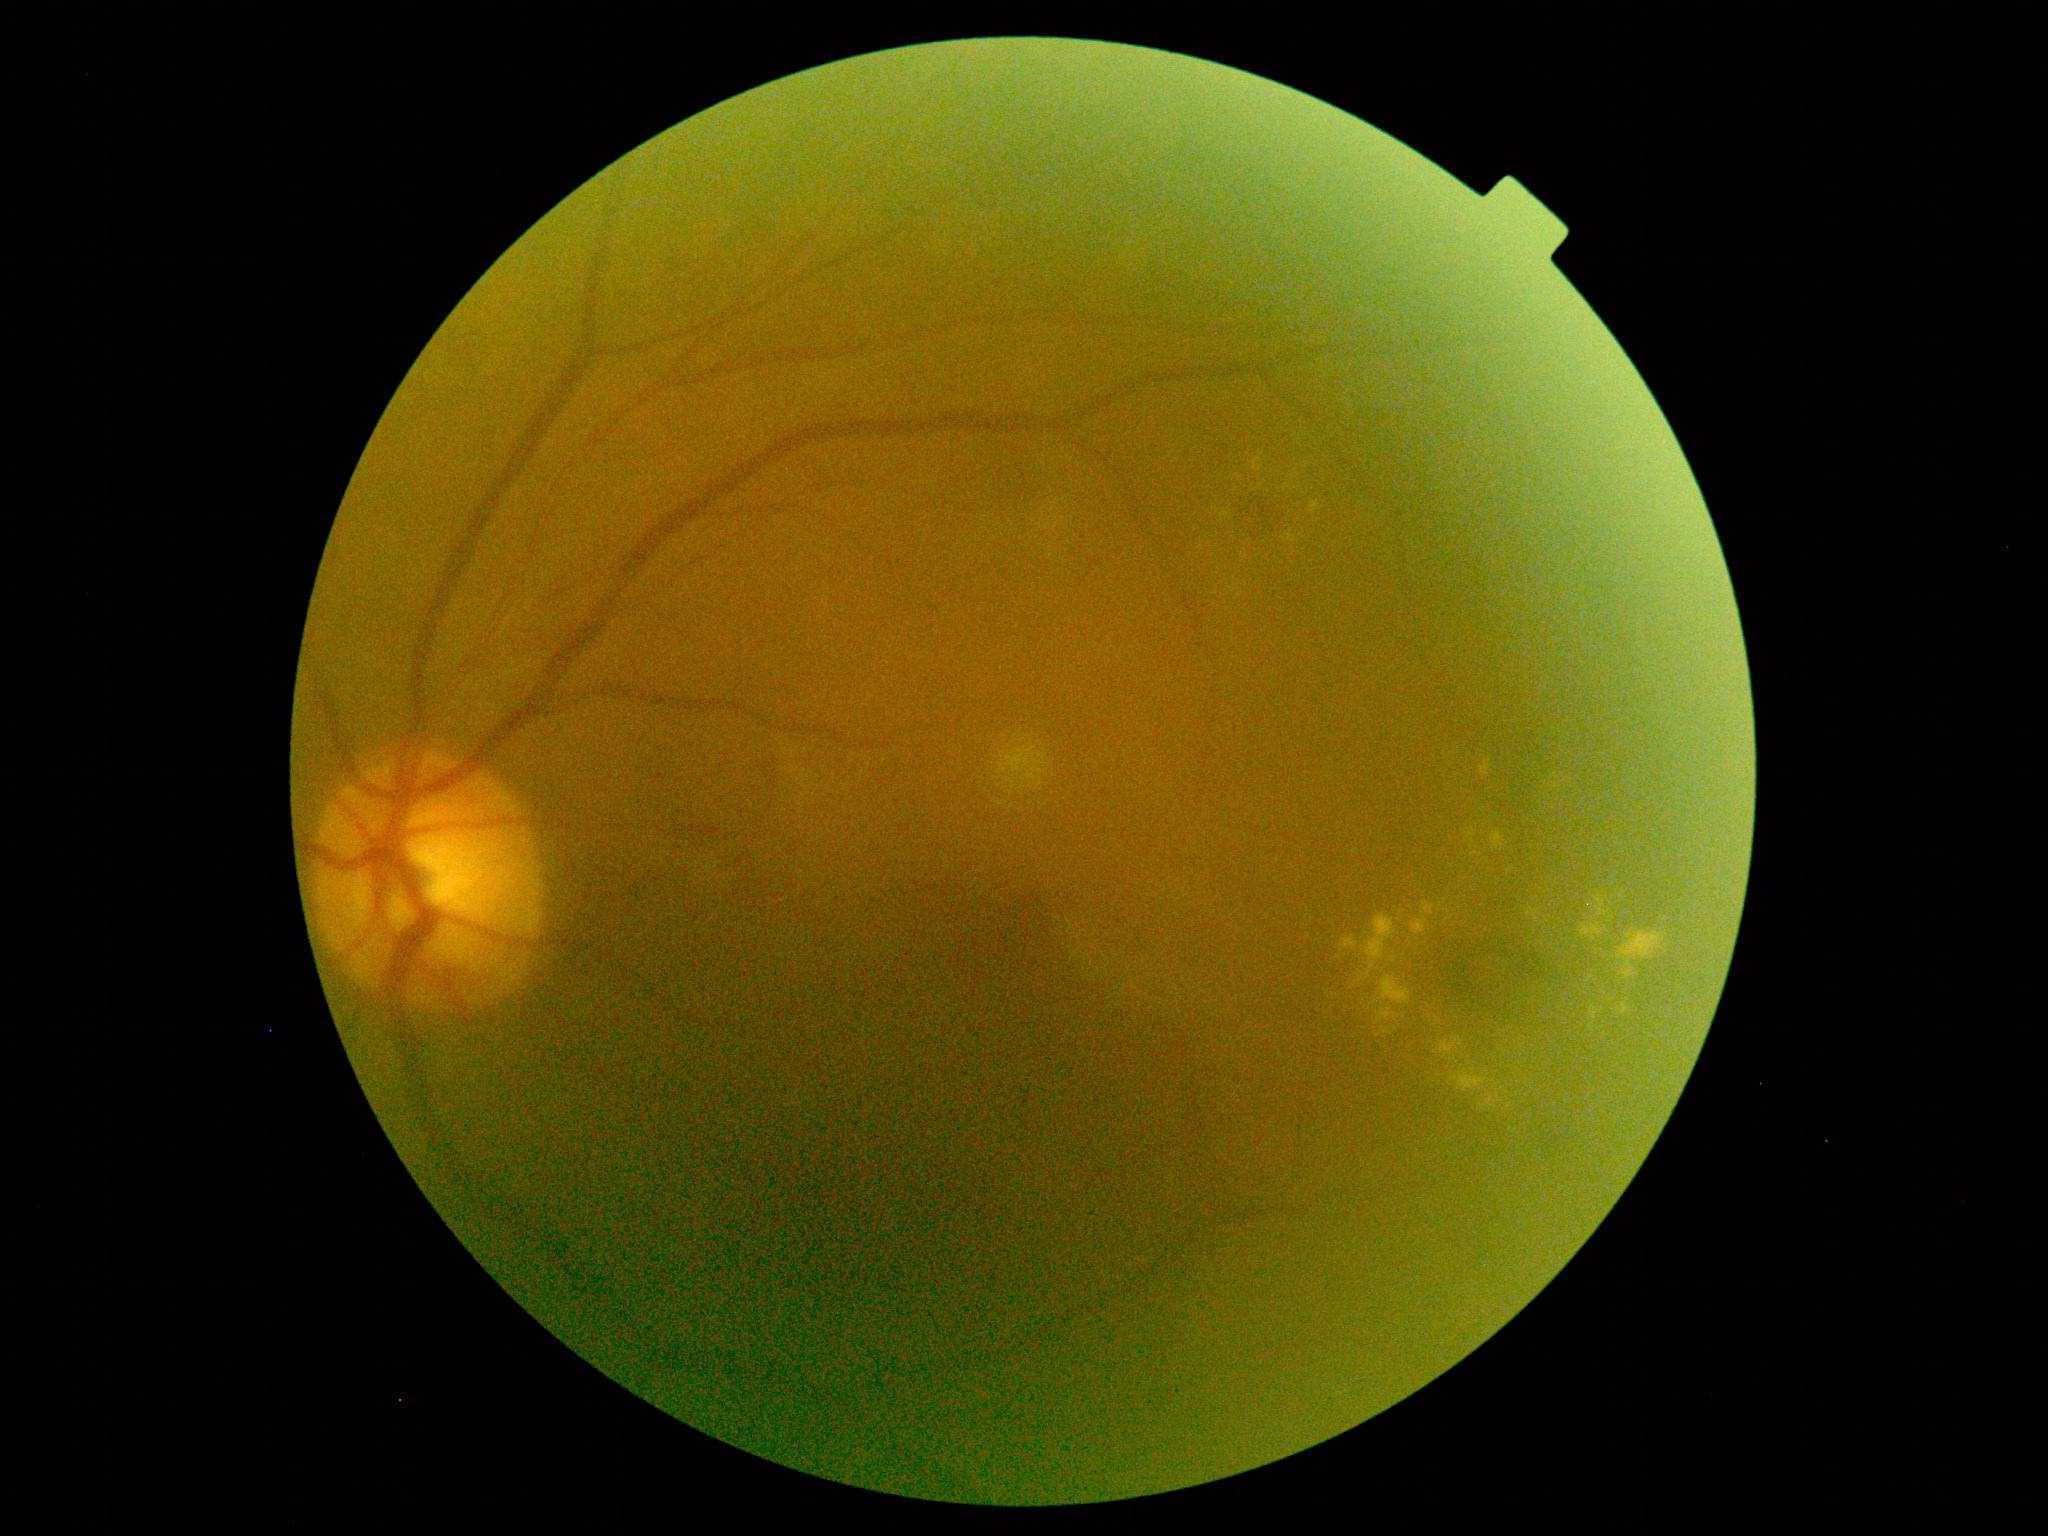

Diabetic retinopathy (DR): moderate non-proliferative diabetic retinopathy (grade 2).